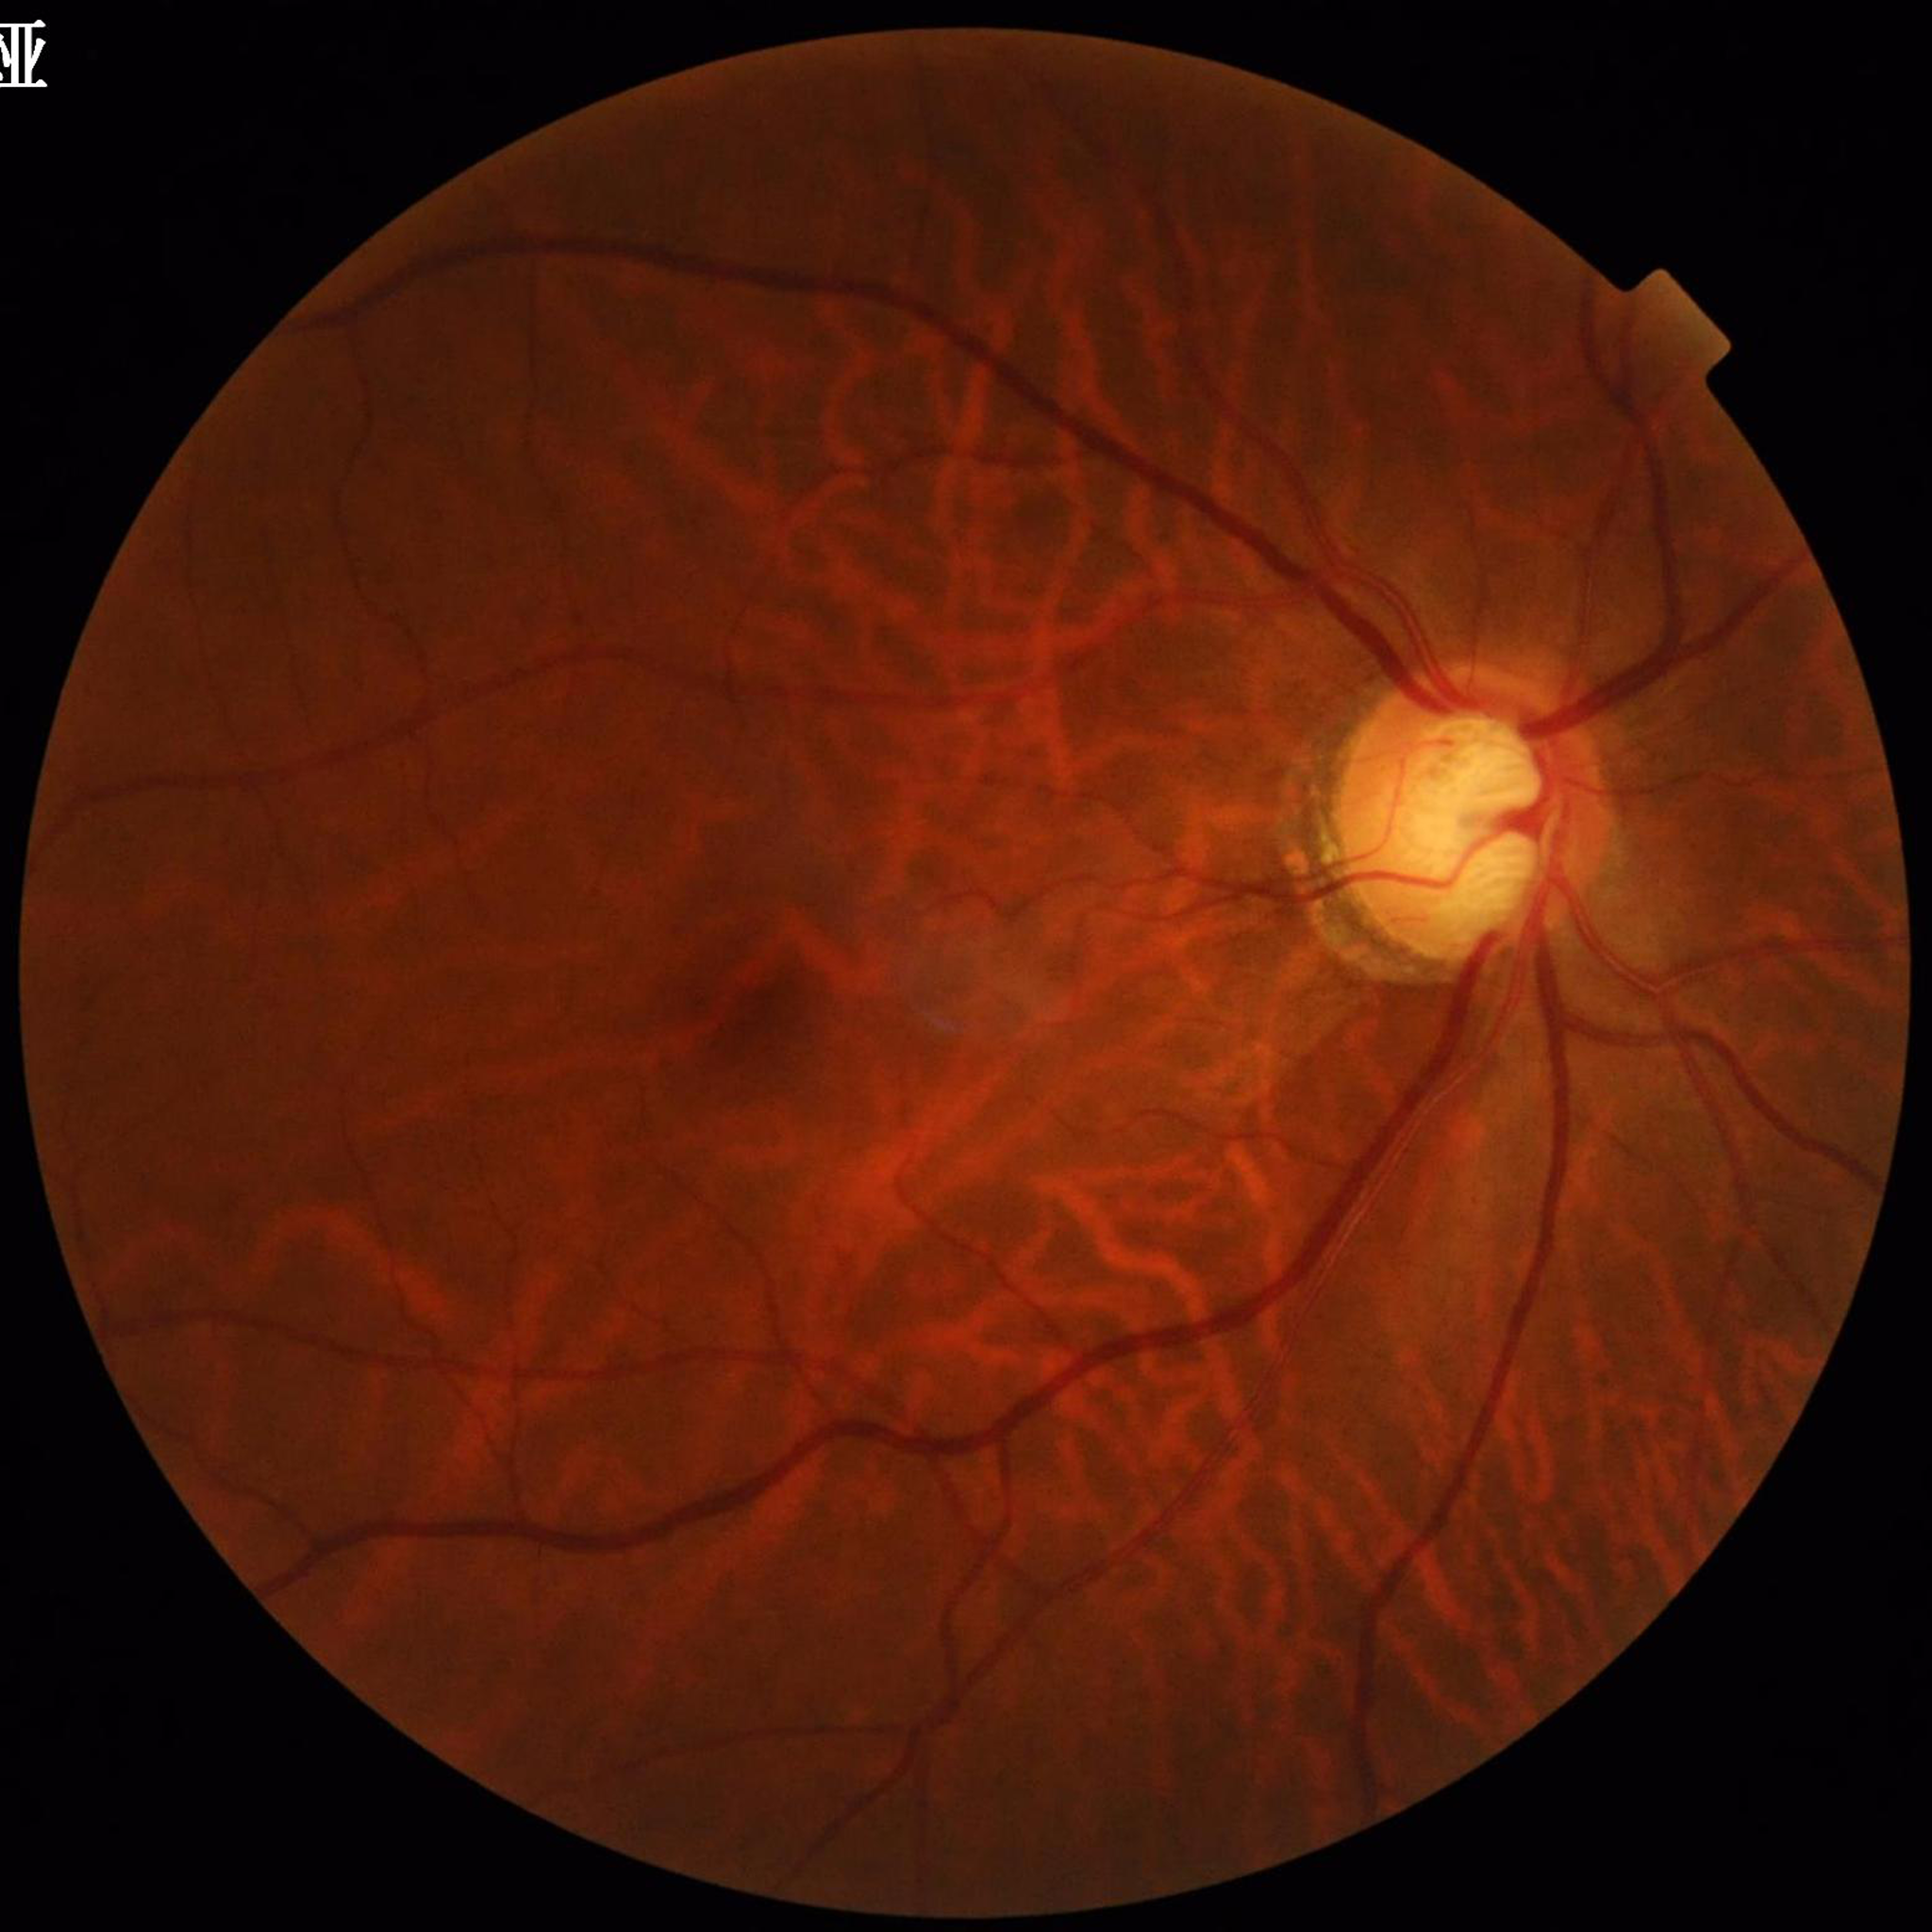

Condition: glaucoma.